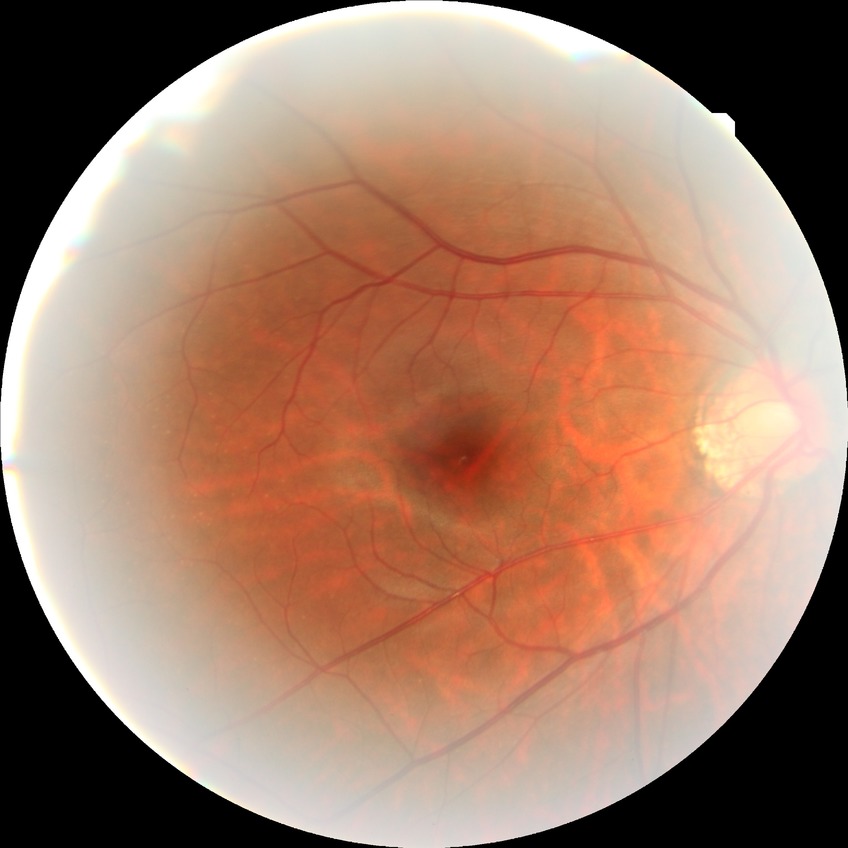

DR severity: NDR.